CFP. 45° field of view.
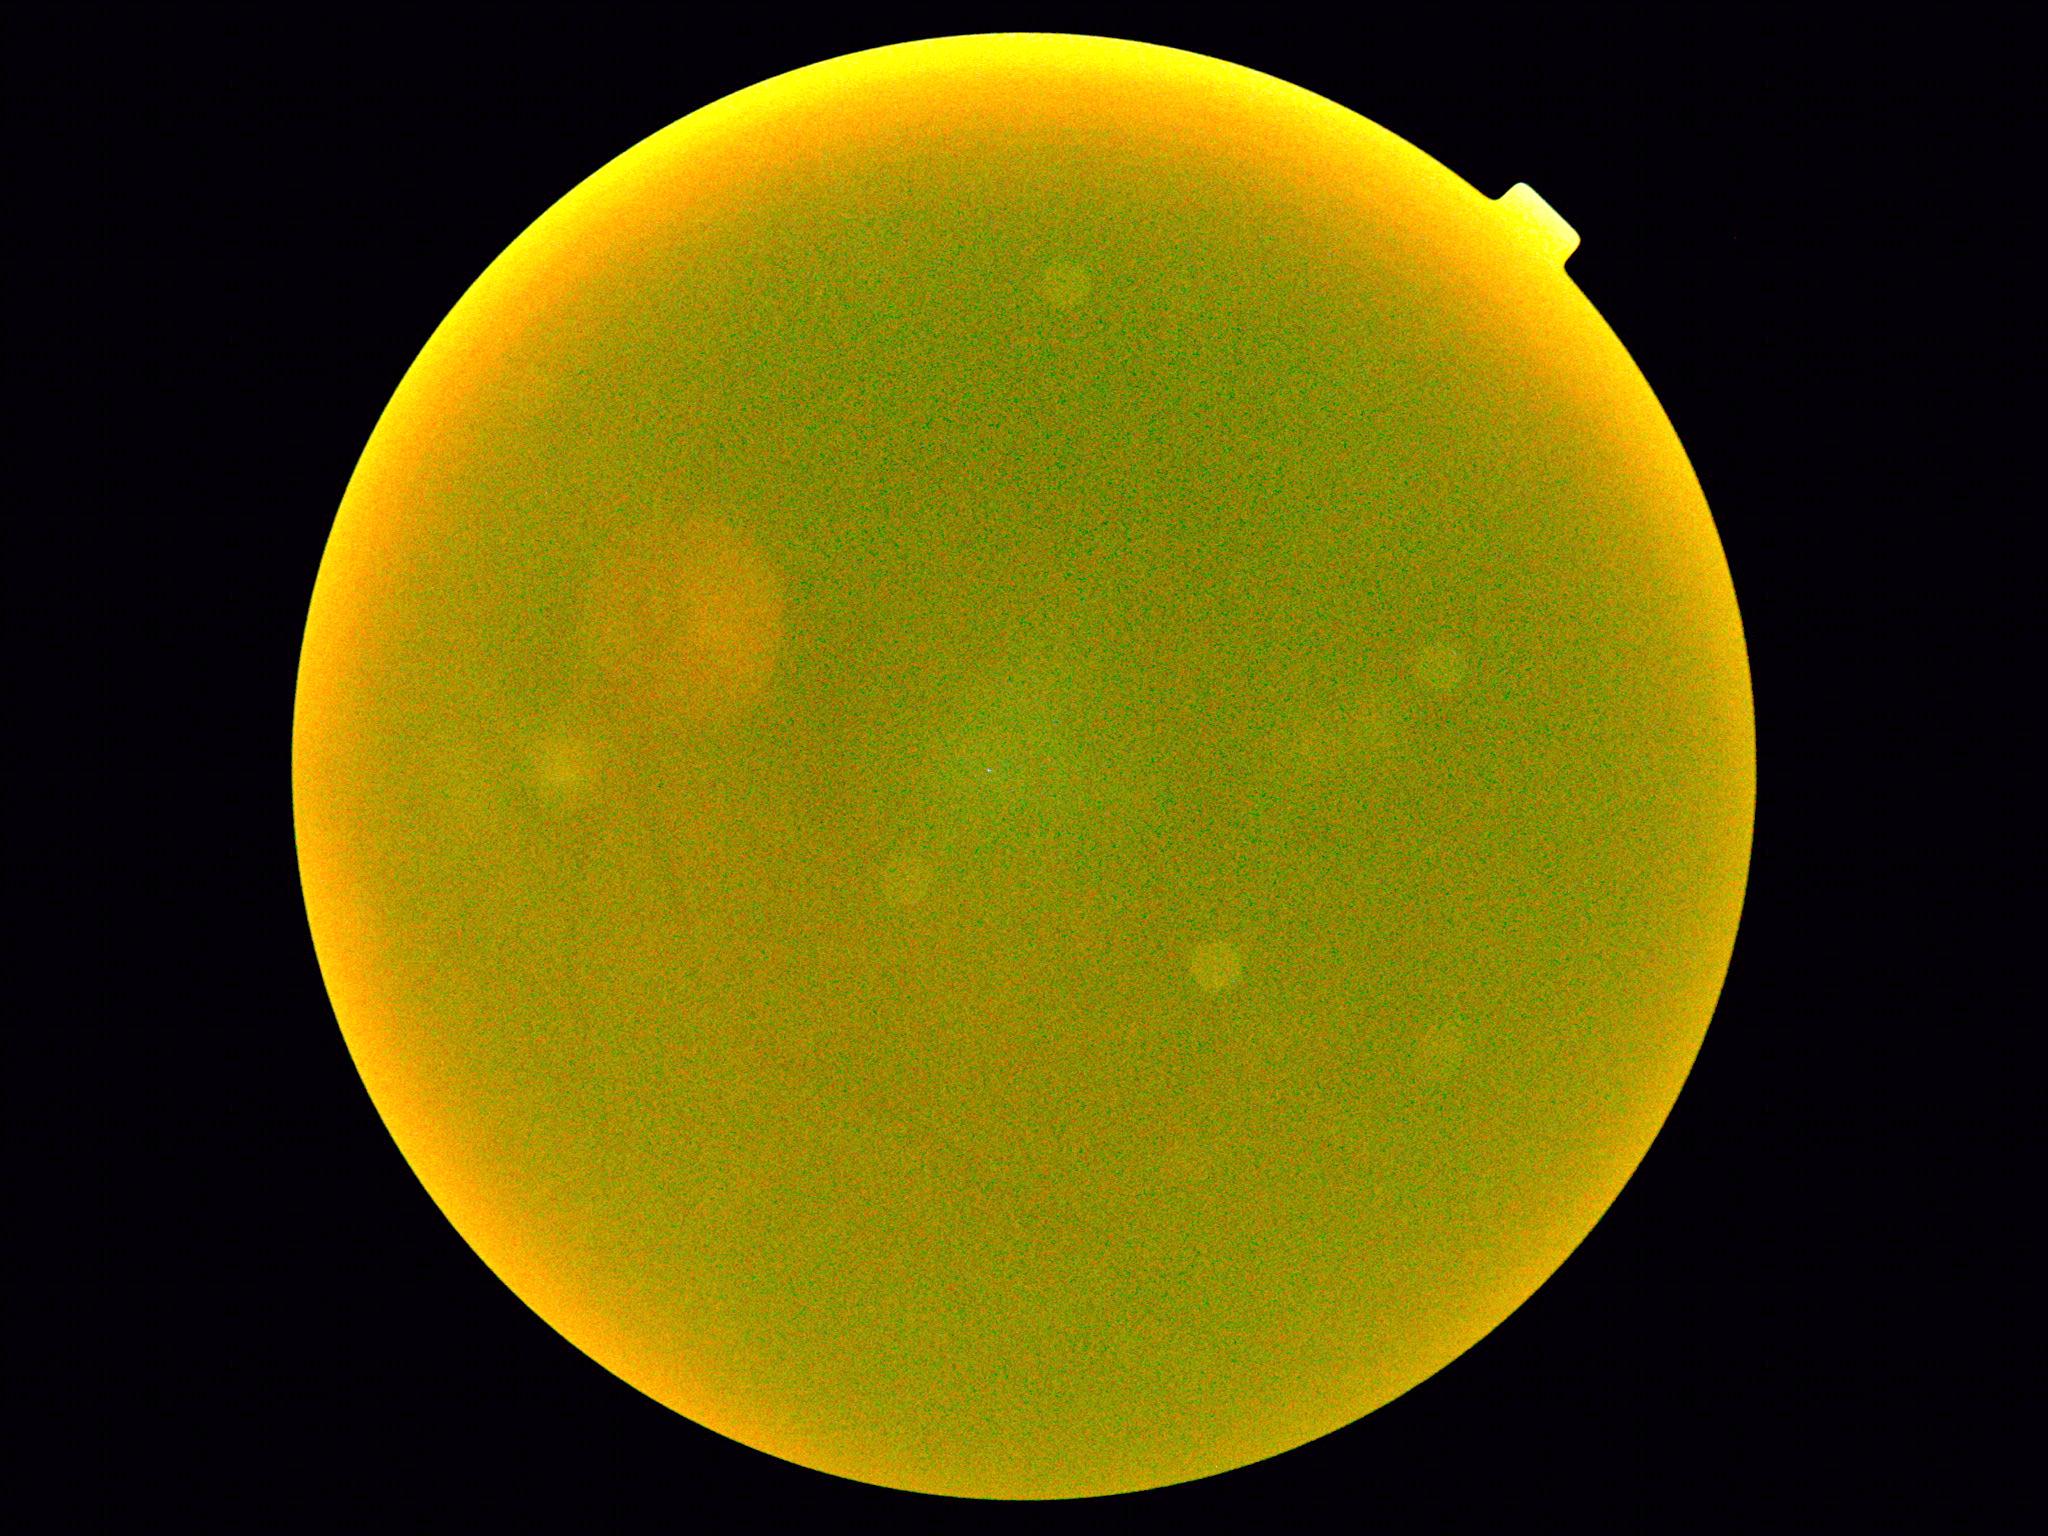

diabetic retinopathy severity = ungradable, image quality = too poor for DR grading.